45° field of view · CFP · 2352x1568.
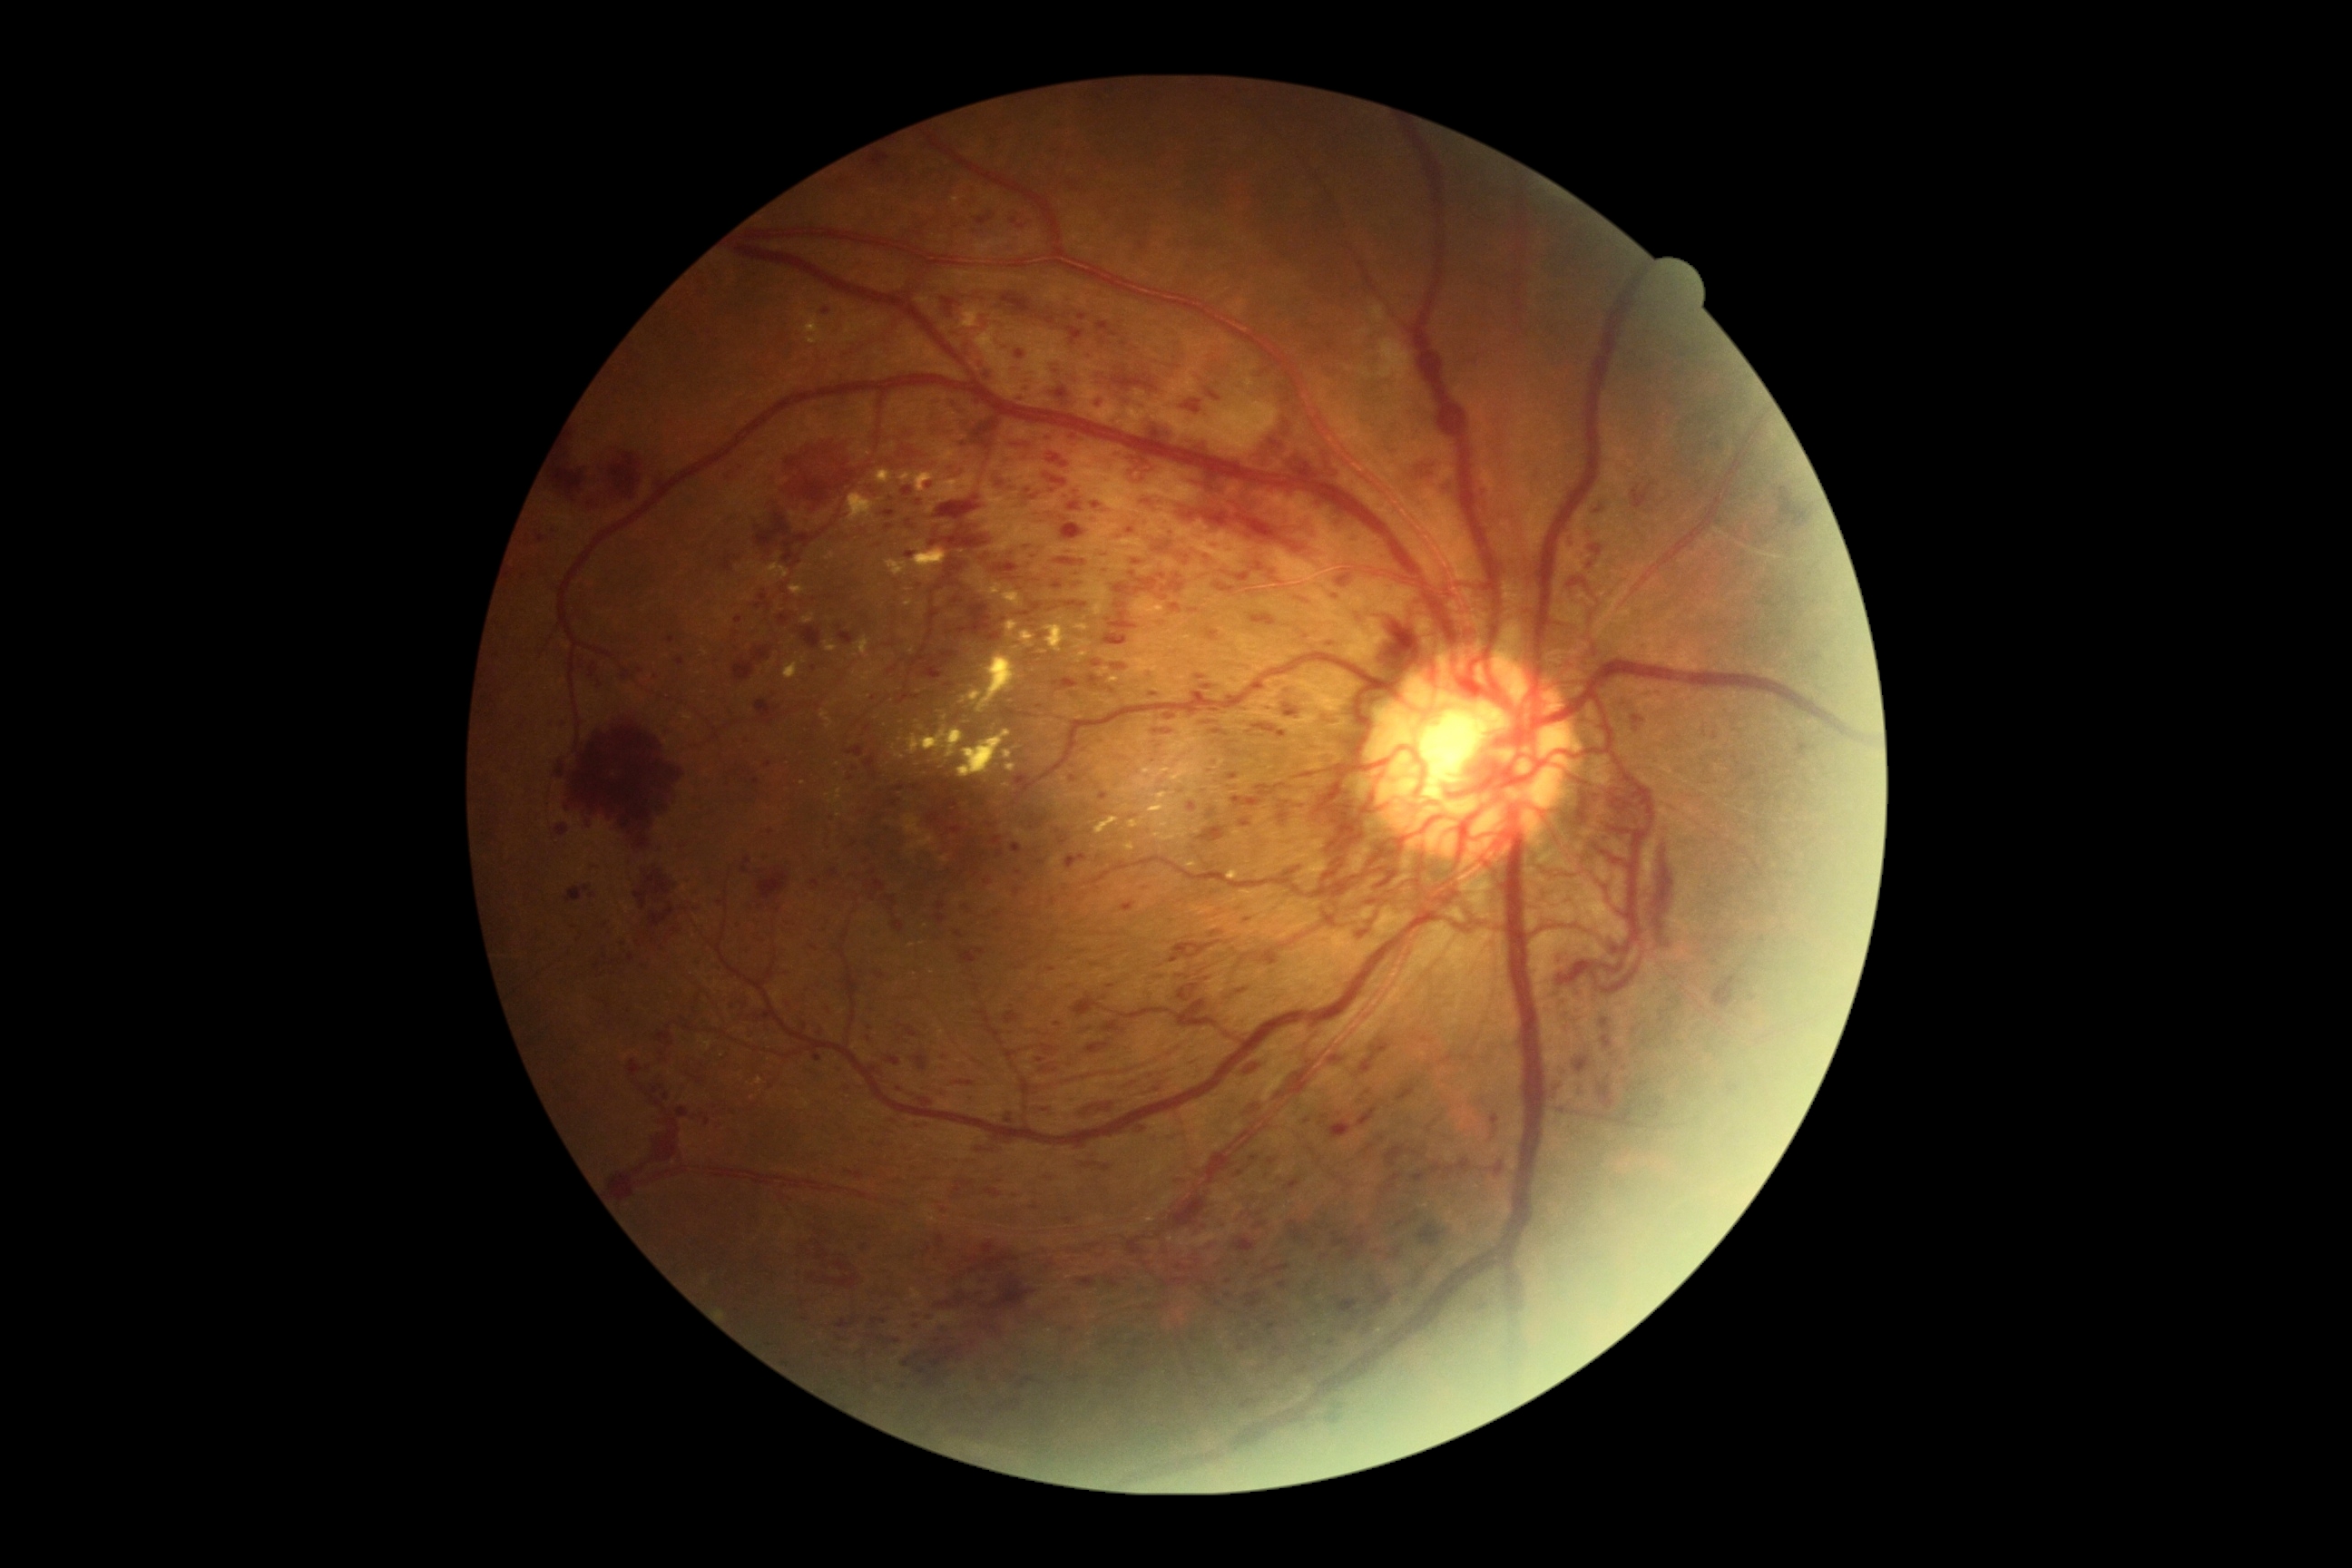

partial: true
dr_grade: 4
dr_grade_name: PDR
lesions:
  ma:
    - x1=1121 y1=901 x2=1137 y2=912
    - x1=1101 y1=981 x2=1110 y2=988
    - x1=997 y1=850 x2=1004 y2=858
    - x1=992 y1=838 x2=1003 y2=847
    - x1=676 y1=658 x2=685 y2=667
    - x1=1378 y1=554 x2=1386 y2=560
    - x1=736 y1=616 x2=743 y2=625
    - x1=1102 y1=569 x2=1112 y2=574
    - x1=738 y1=921 x2=747 y2=926
    - x1=1255 y1=1366 x2=1266 y2=1377
  ma_small_approx:
    - pt(1248, 920)
    - pt(1021, 228)
    - pt(1208, 557)
    - pt(902, 1089)
    - pt(1090, 1030)
    - pt(719, 901)
    - pt(1013, 555)
  he:
    - x1=1398 y1=1220 x2=1406 y2=1228
    - x1=1632 y1=716 x2=1647 y2=732
    - x1=598 y1=680 x2=602 y2=689
    - x1=1598 y1=1075 x2=1616 y2=1112
    - x1=1442 y1=484 x2=1455 y2=495
    - x1=943 y1=299 x2=961 y2=317
    - x1=874 y1=879 x2=887 y2=892
    - x1=897 y1=1024 x2=919 y2=1037
    - x1=888 y1=667 x2=897 y2=674
    - x1=956 y1=1081 x2=974 y2=1086
    - x1=923 y1=1246 x2=932 y2=1255
    - x1=651 y1=1133 x2=681 y2=1166
    - x1=963 y1=317 x2=992 y2=373
    - x1=1066 y1=1001 x2=1093 y2=1019
    - x1=779 y1=442 x2=852 y2=513
    - x1=1184 y1=1003 x2=1204 y2=1023
    - x1=1004 y1=1012 x2=1019 y2=1024
  he_small_approx:
    - pt(944, 1211)
    - pt(962, 1135)